45° FOV
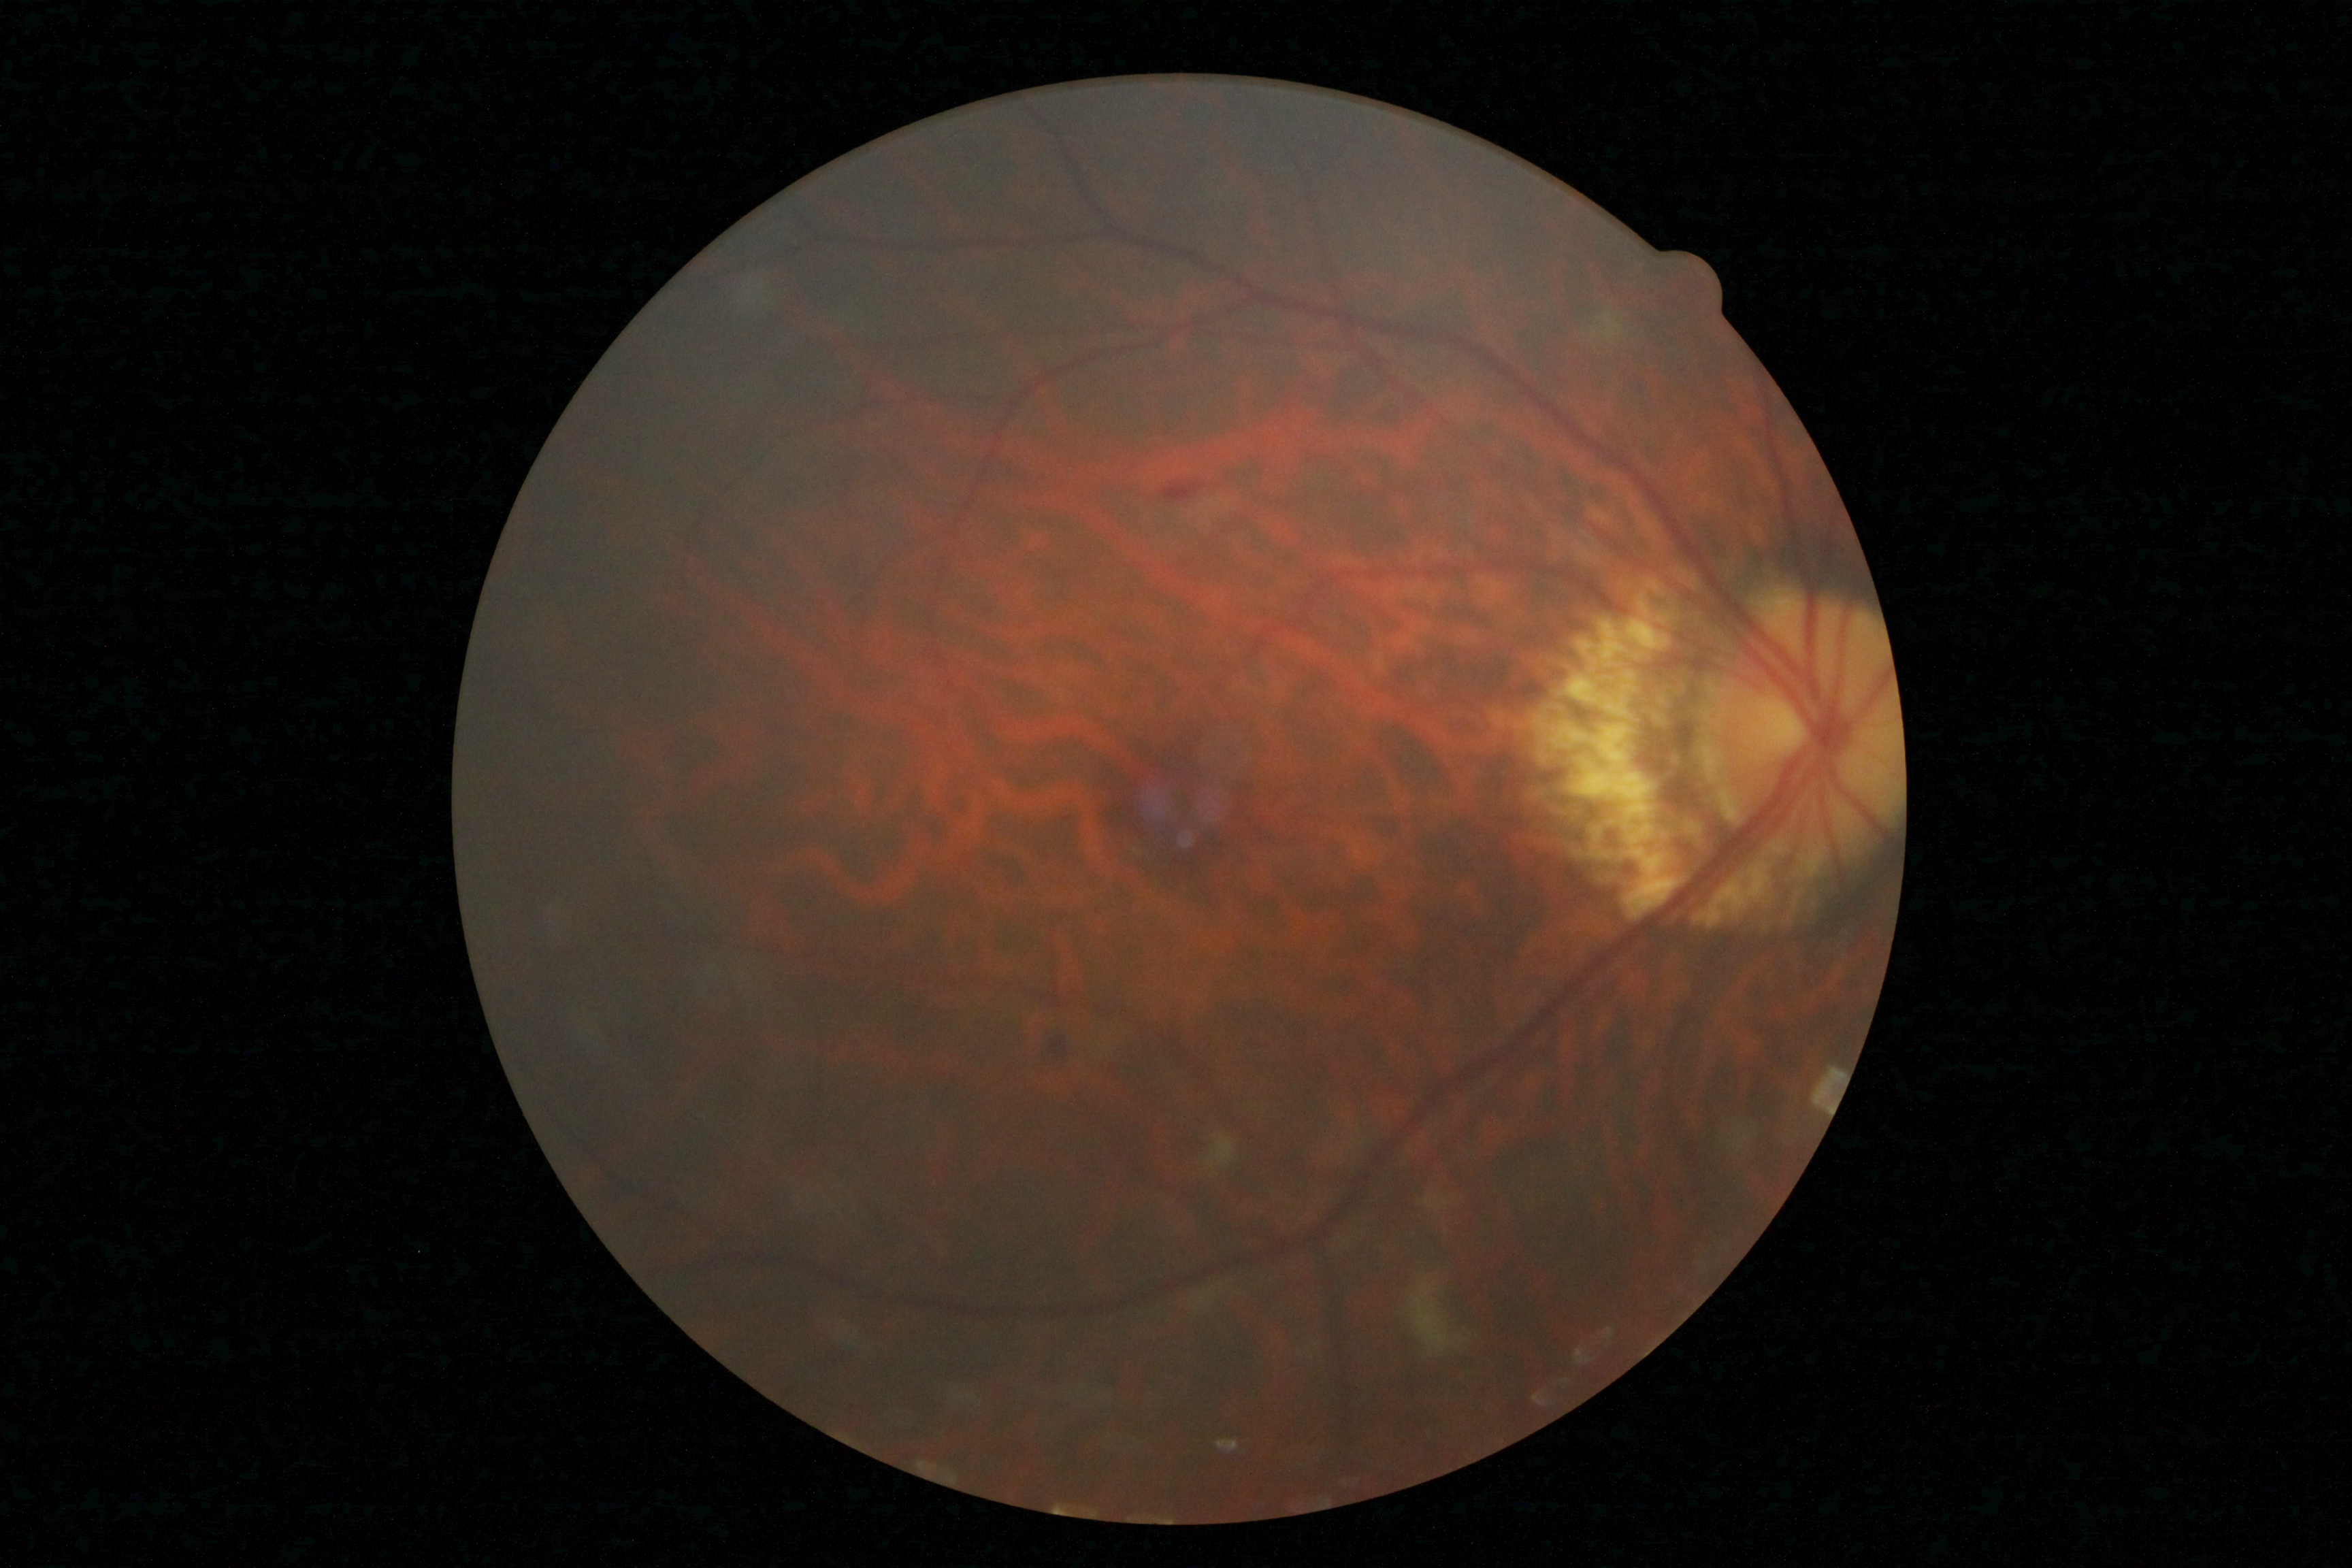

The retinopathy is classified as non-proliferative diabetic retinopathy. DR grade is moderate non-proliferative diabetic retinopathy (2) — more than just microaneurysms but less than severe NPDR.